Forus 3Nethra fundus camera. 2048 by 1536 pixels
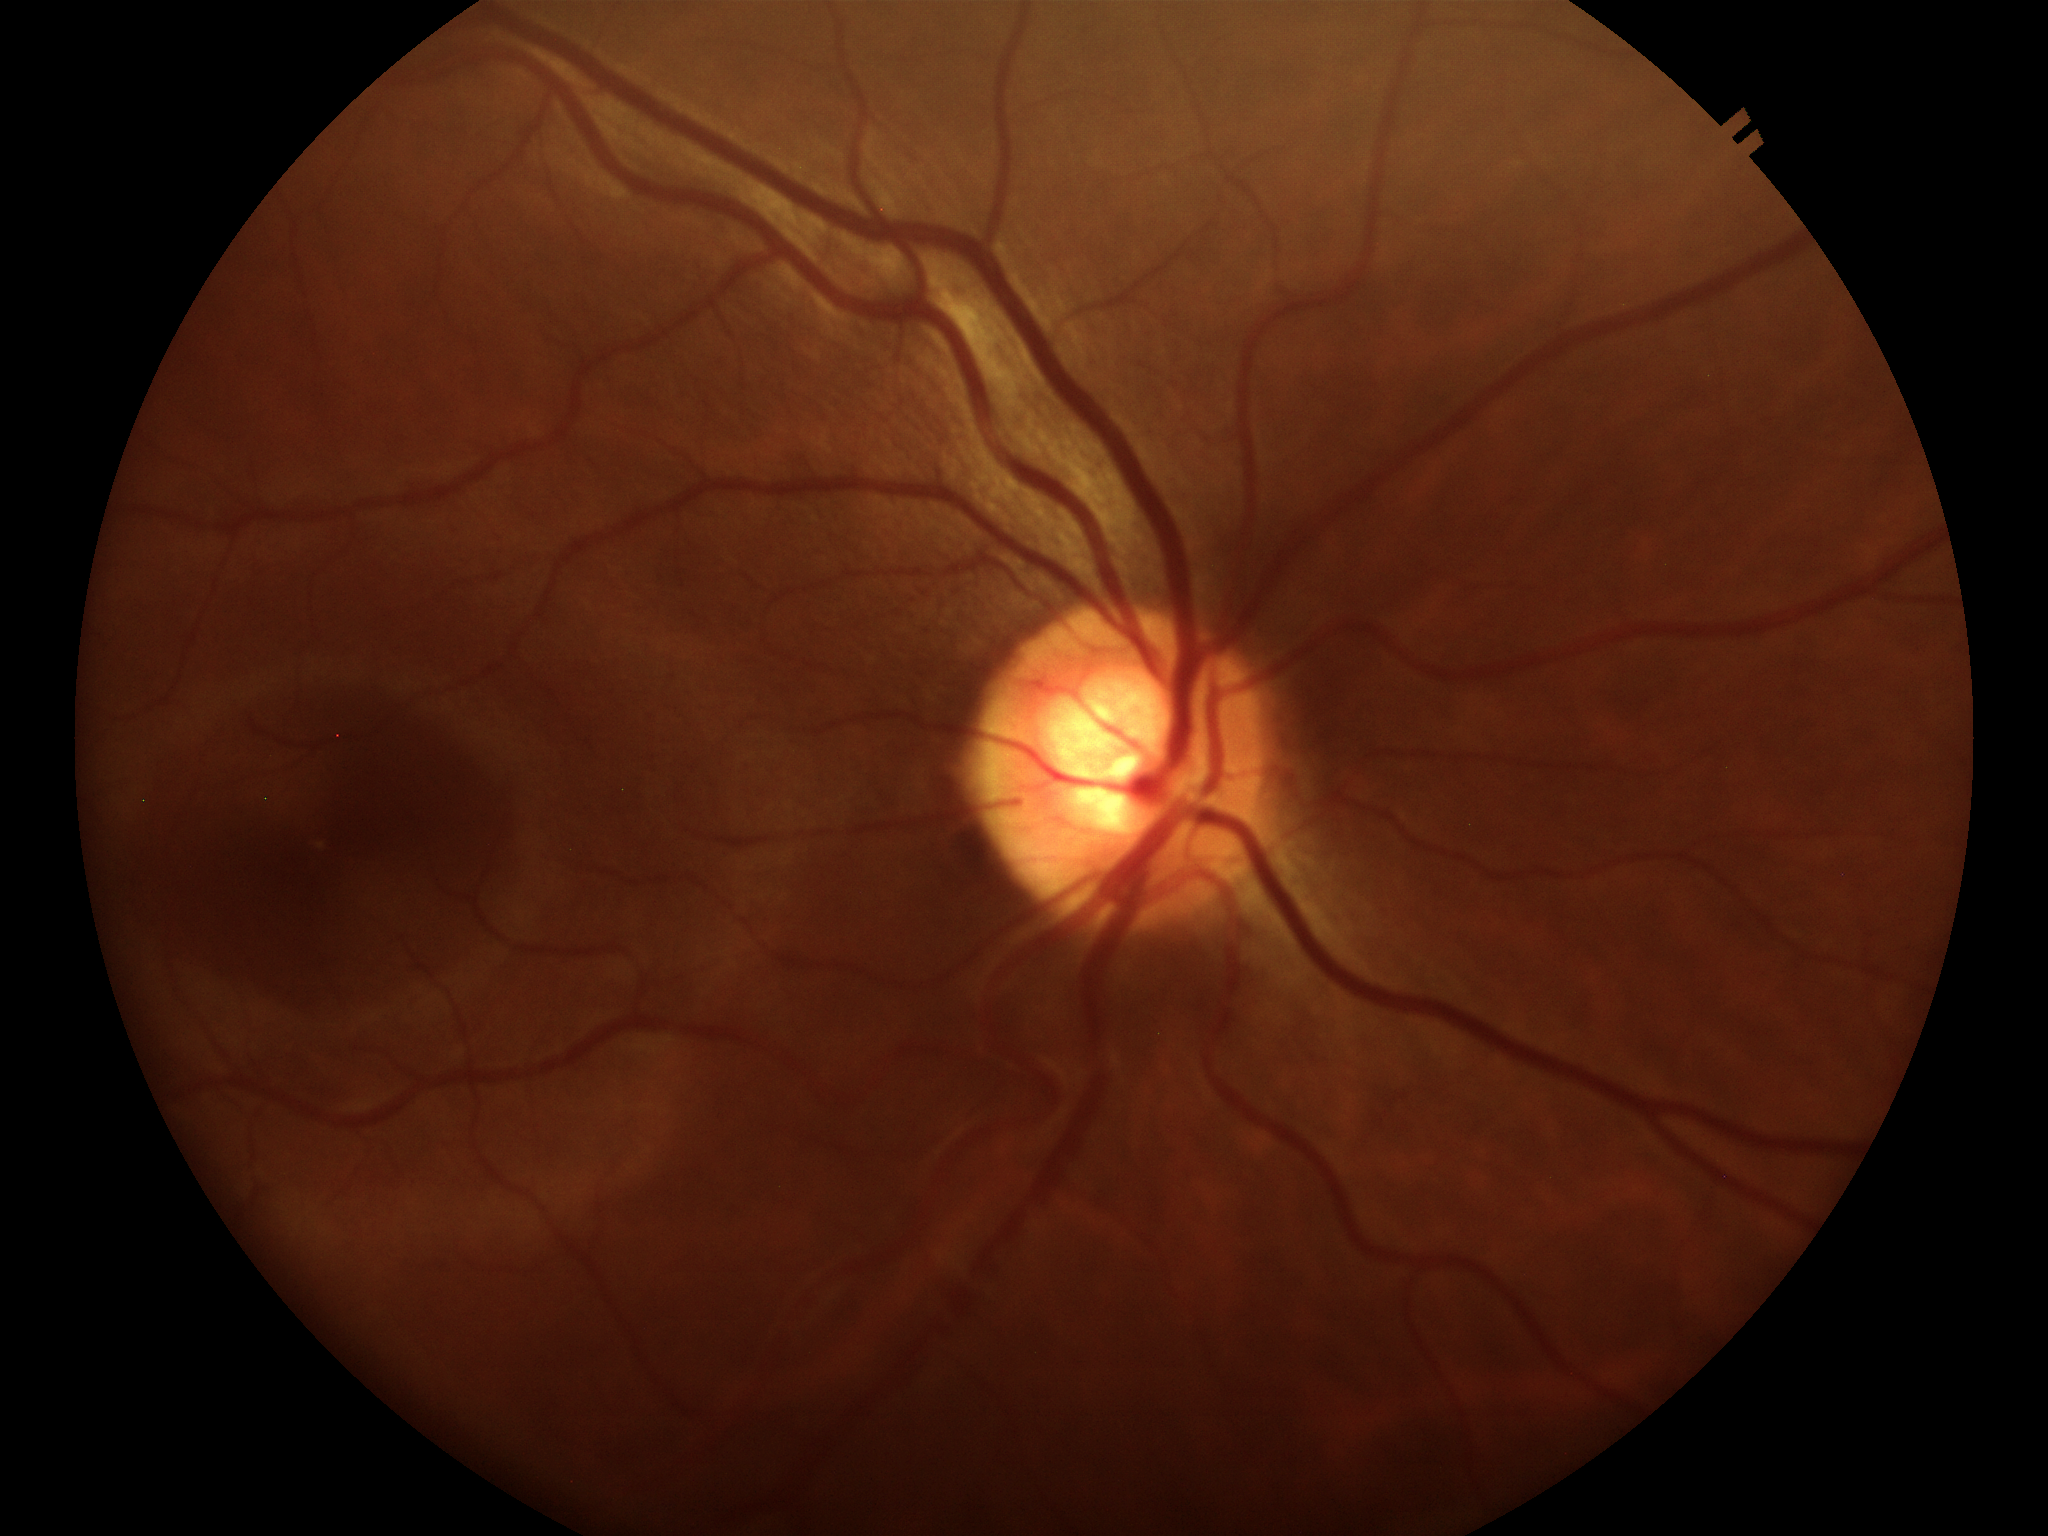 {
  "vcdr": "0.57",
  "glaucoma_decision": "no suspicious findings"
}